Nonmydriatic. NIDEK AFC-230 fundus camera. 45 degree fundus photograph. 848 by 848 pixels. Modified Davis classification: 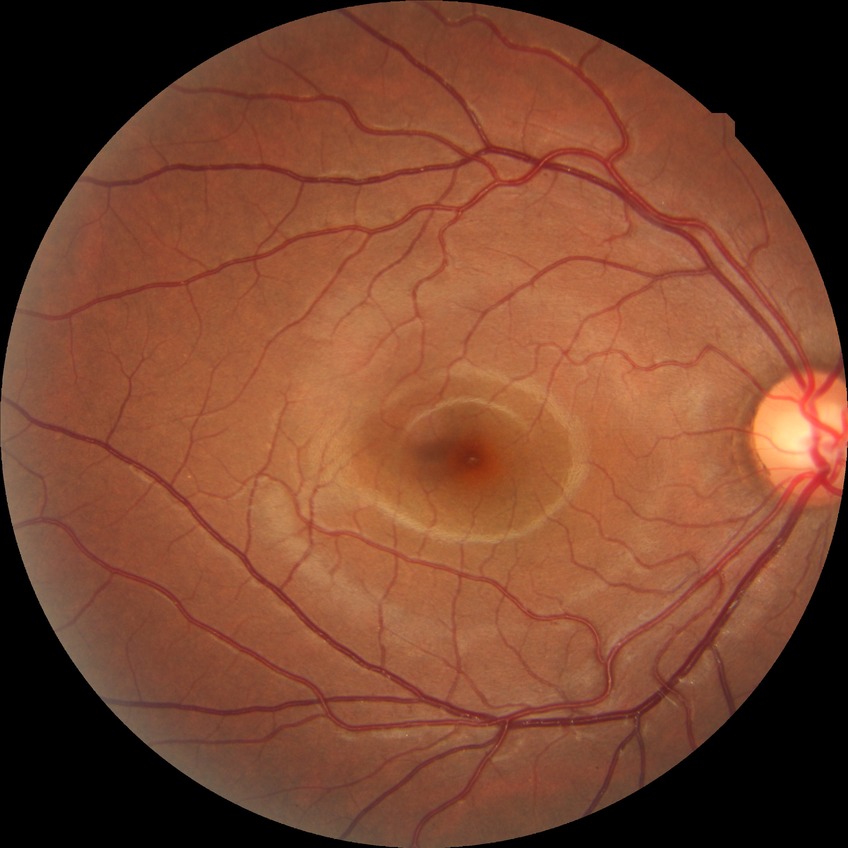
diabetic retinopathy (DR)=NDR (no diabetic retinopathy).